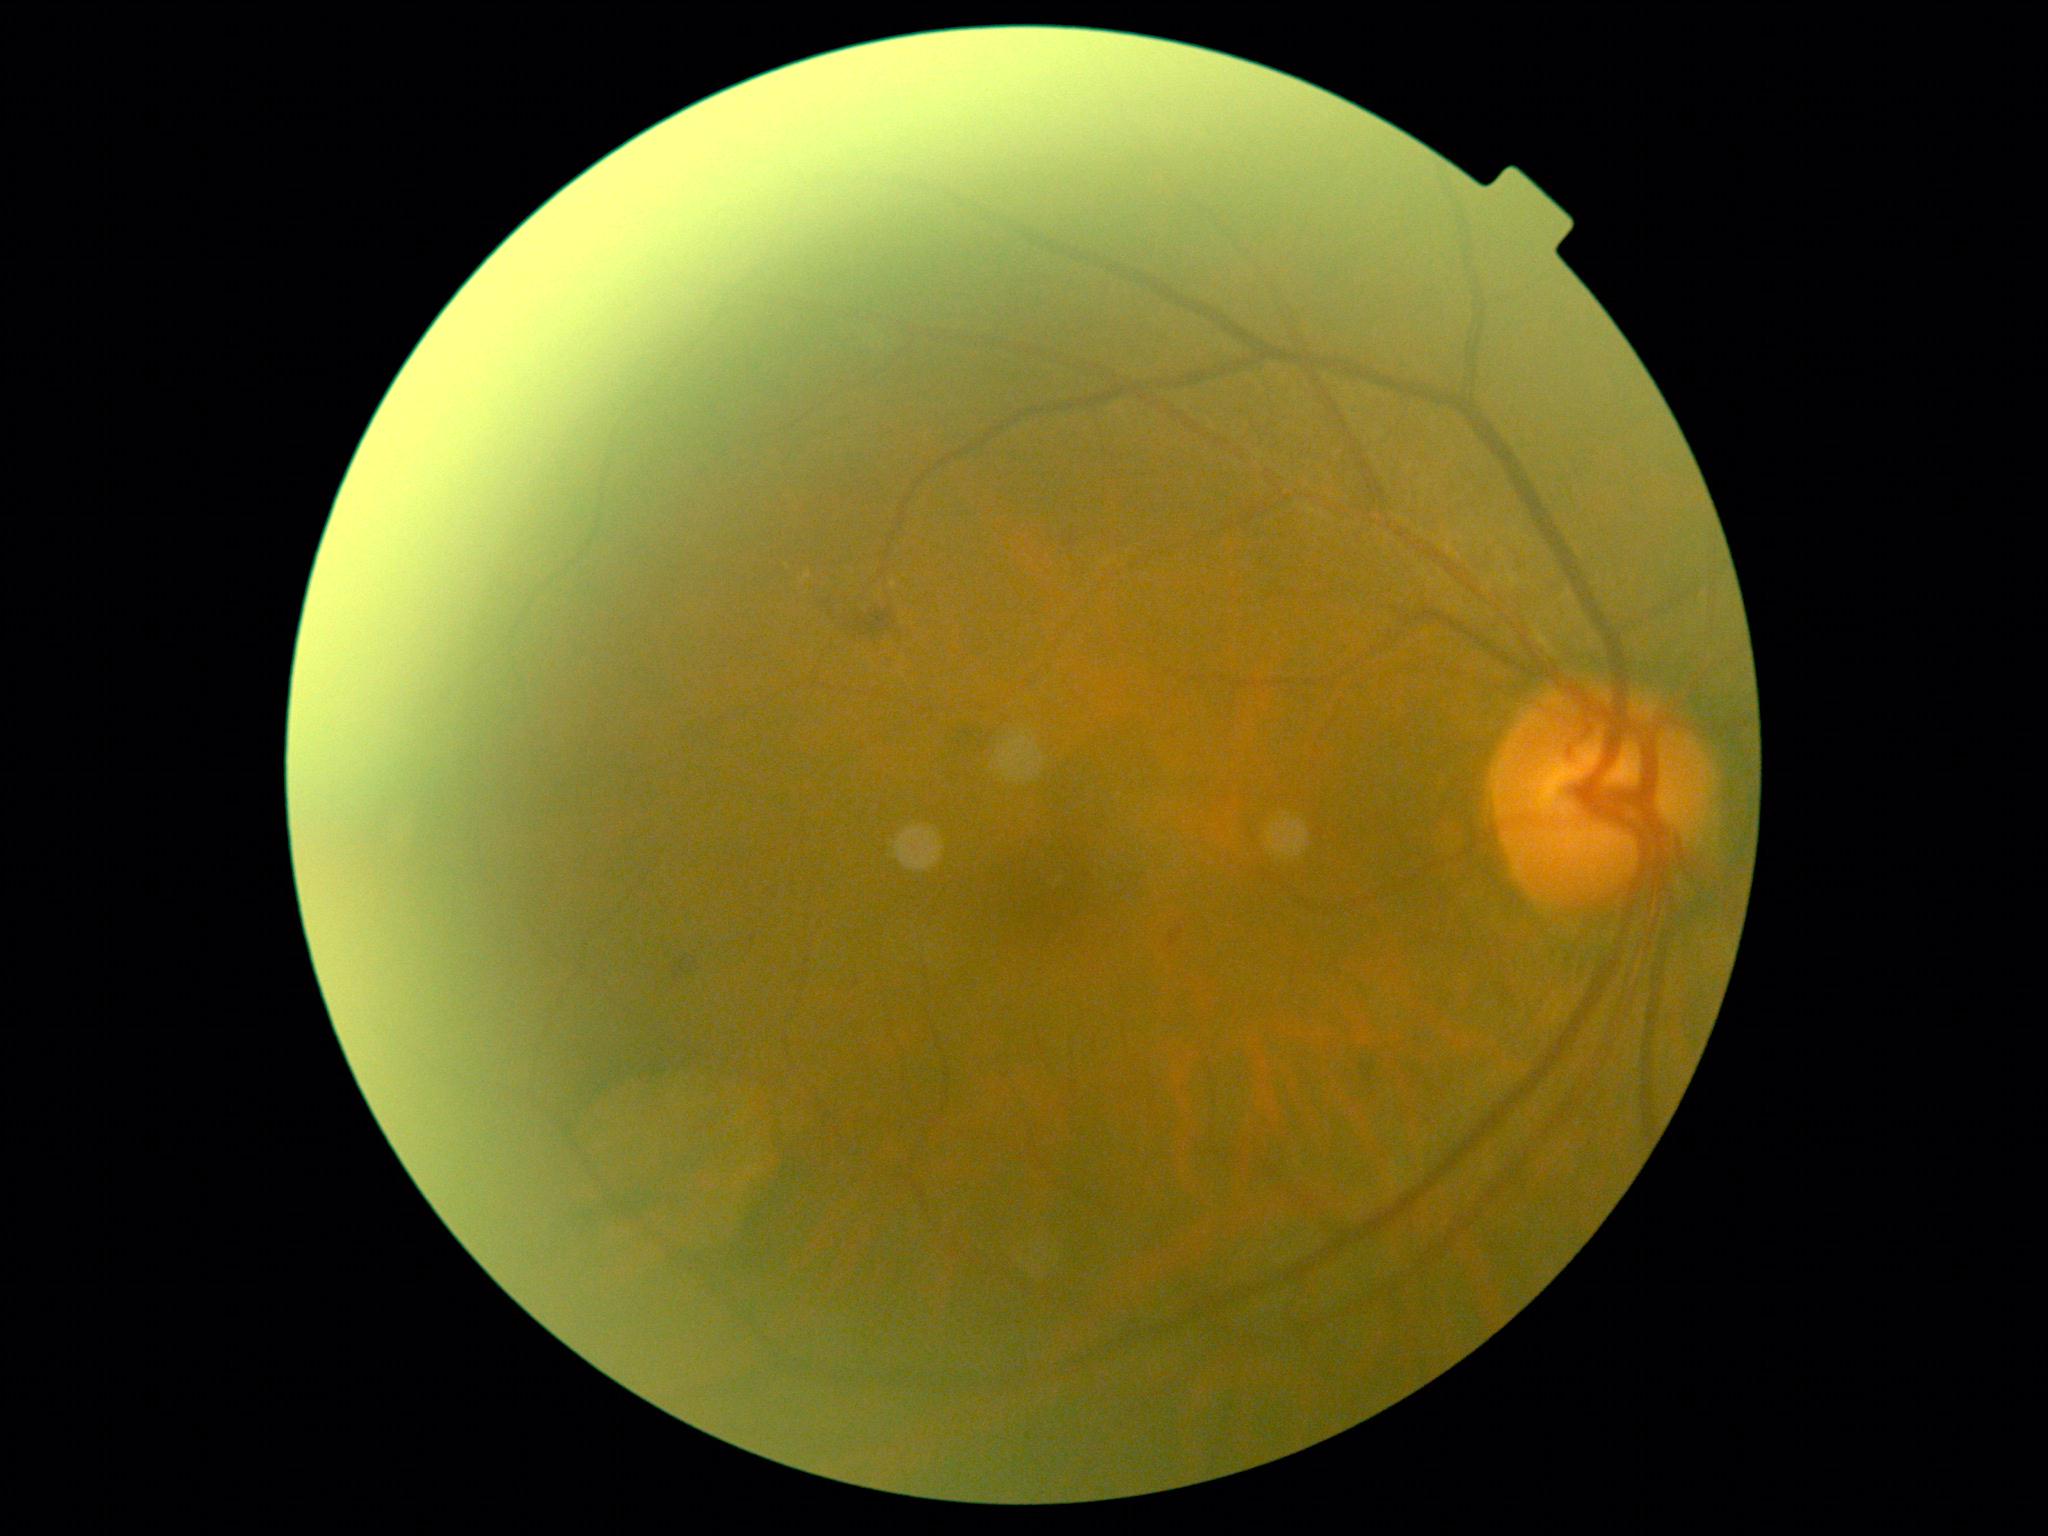
DR grade is moderate NPDR (2).